2048 by 1536 pixels: 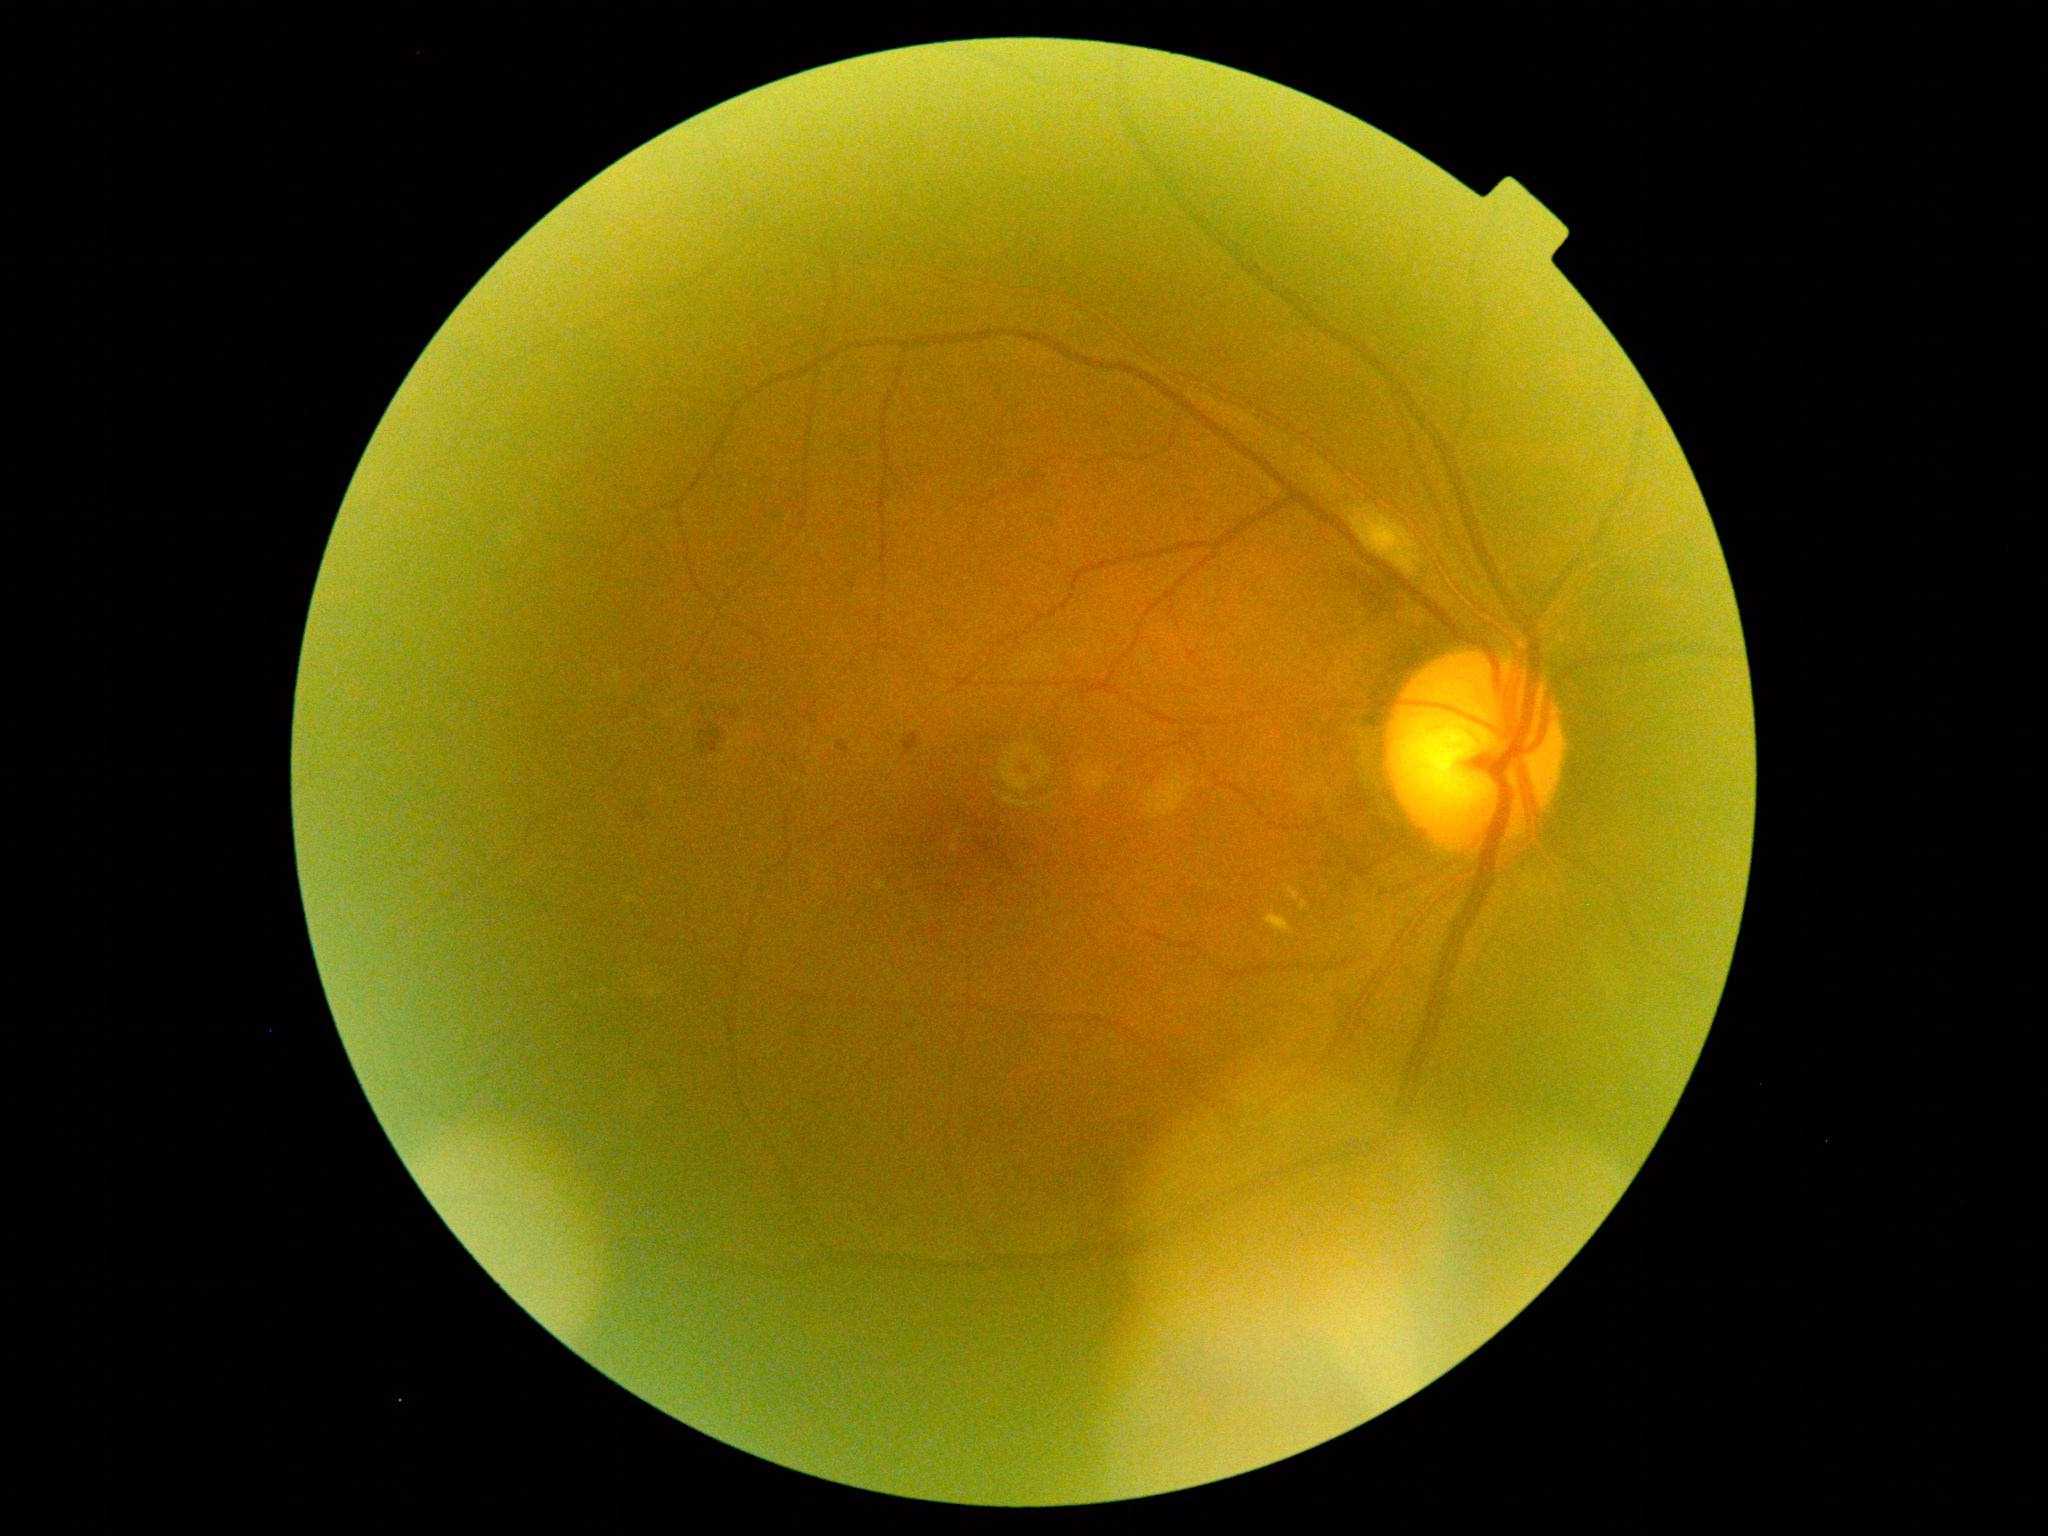

DR grade: 2 (moderate NPDR).